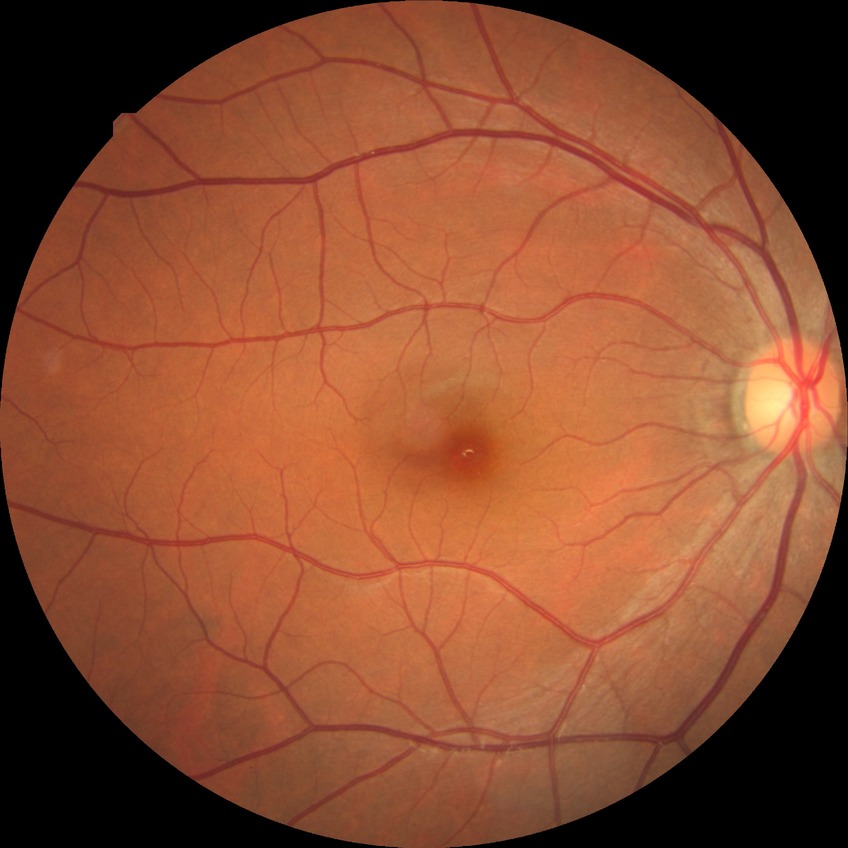
• Davis stage — NDR
• DR impression — no signs of DR